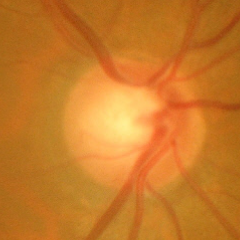
Glaucomatous changes are present.
Advanced-stage glaucoma.